Image size 1536x1152 · 45° field of view:
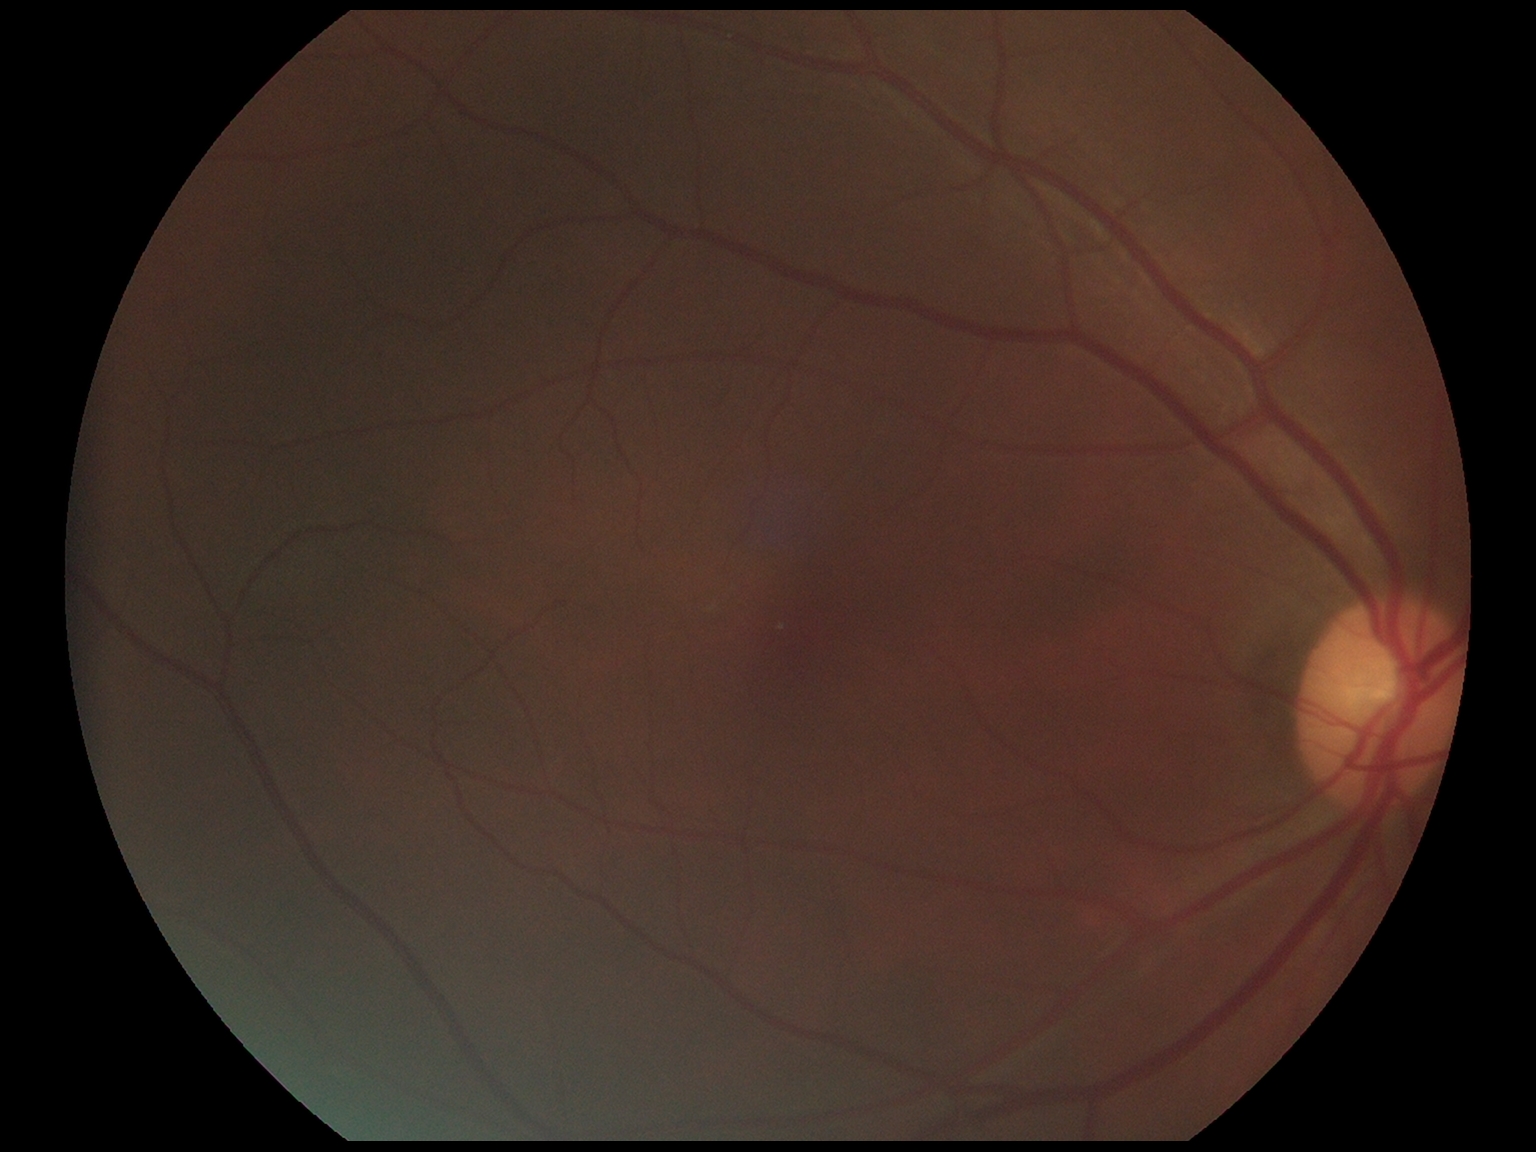 Diabetic retinopathy is grade 0 (no apparent retinopathy).
No diabetic retinal disease findings.